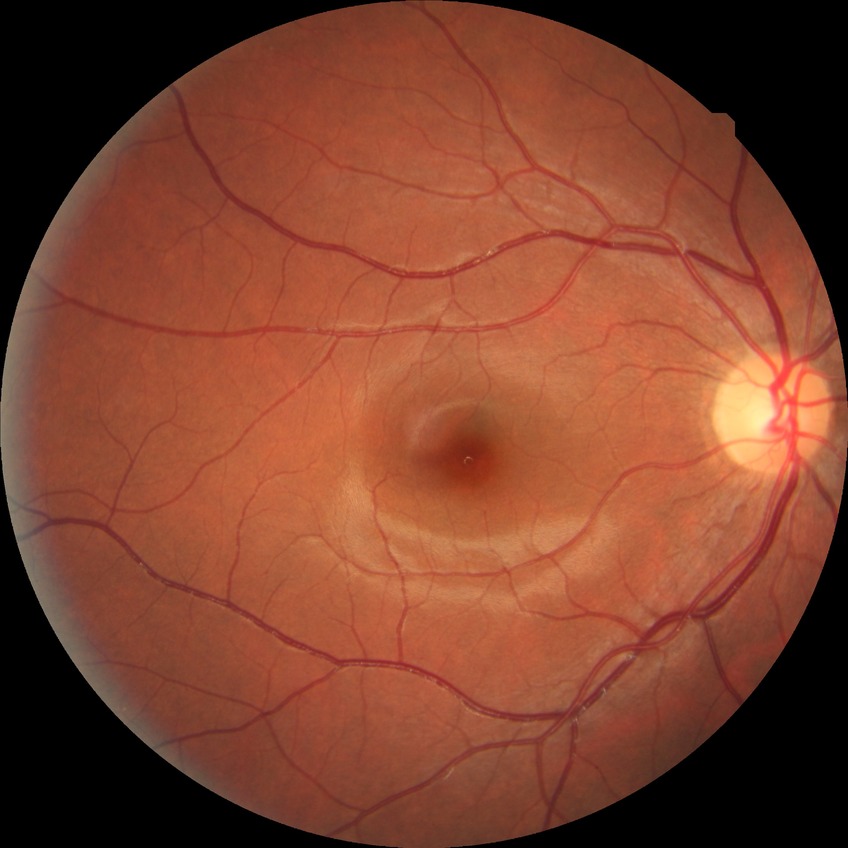
  davis_grade: no diabetic retinopathy